Pediatric retinal photograph (wide-field) · 640x480px — 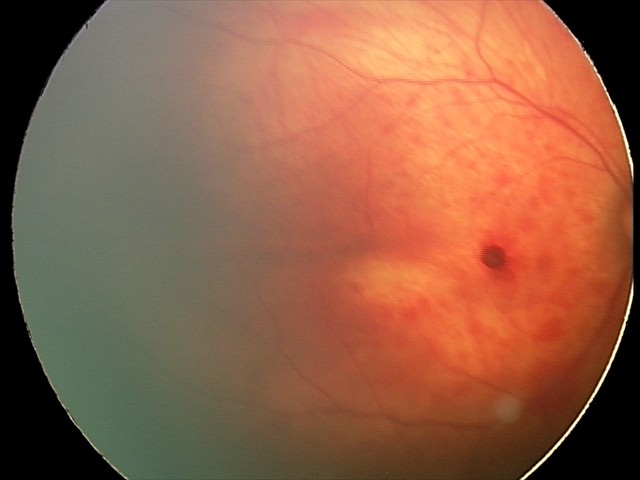

Diagnosis from this screening exam: retinal hemorrhages.